640 by 480 pixels; infant wide-field retinal image:
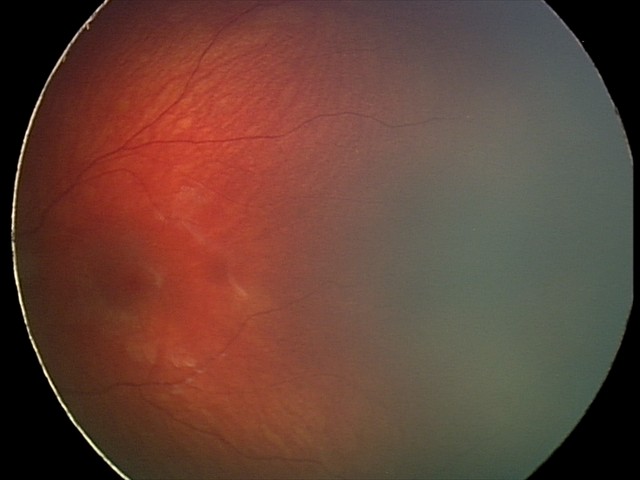 Screening series with retinal hemorrhages.